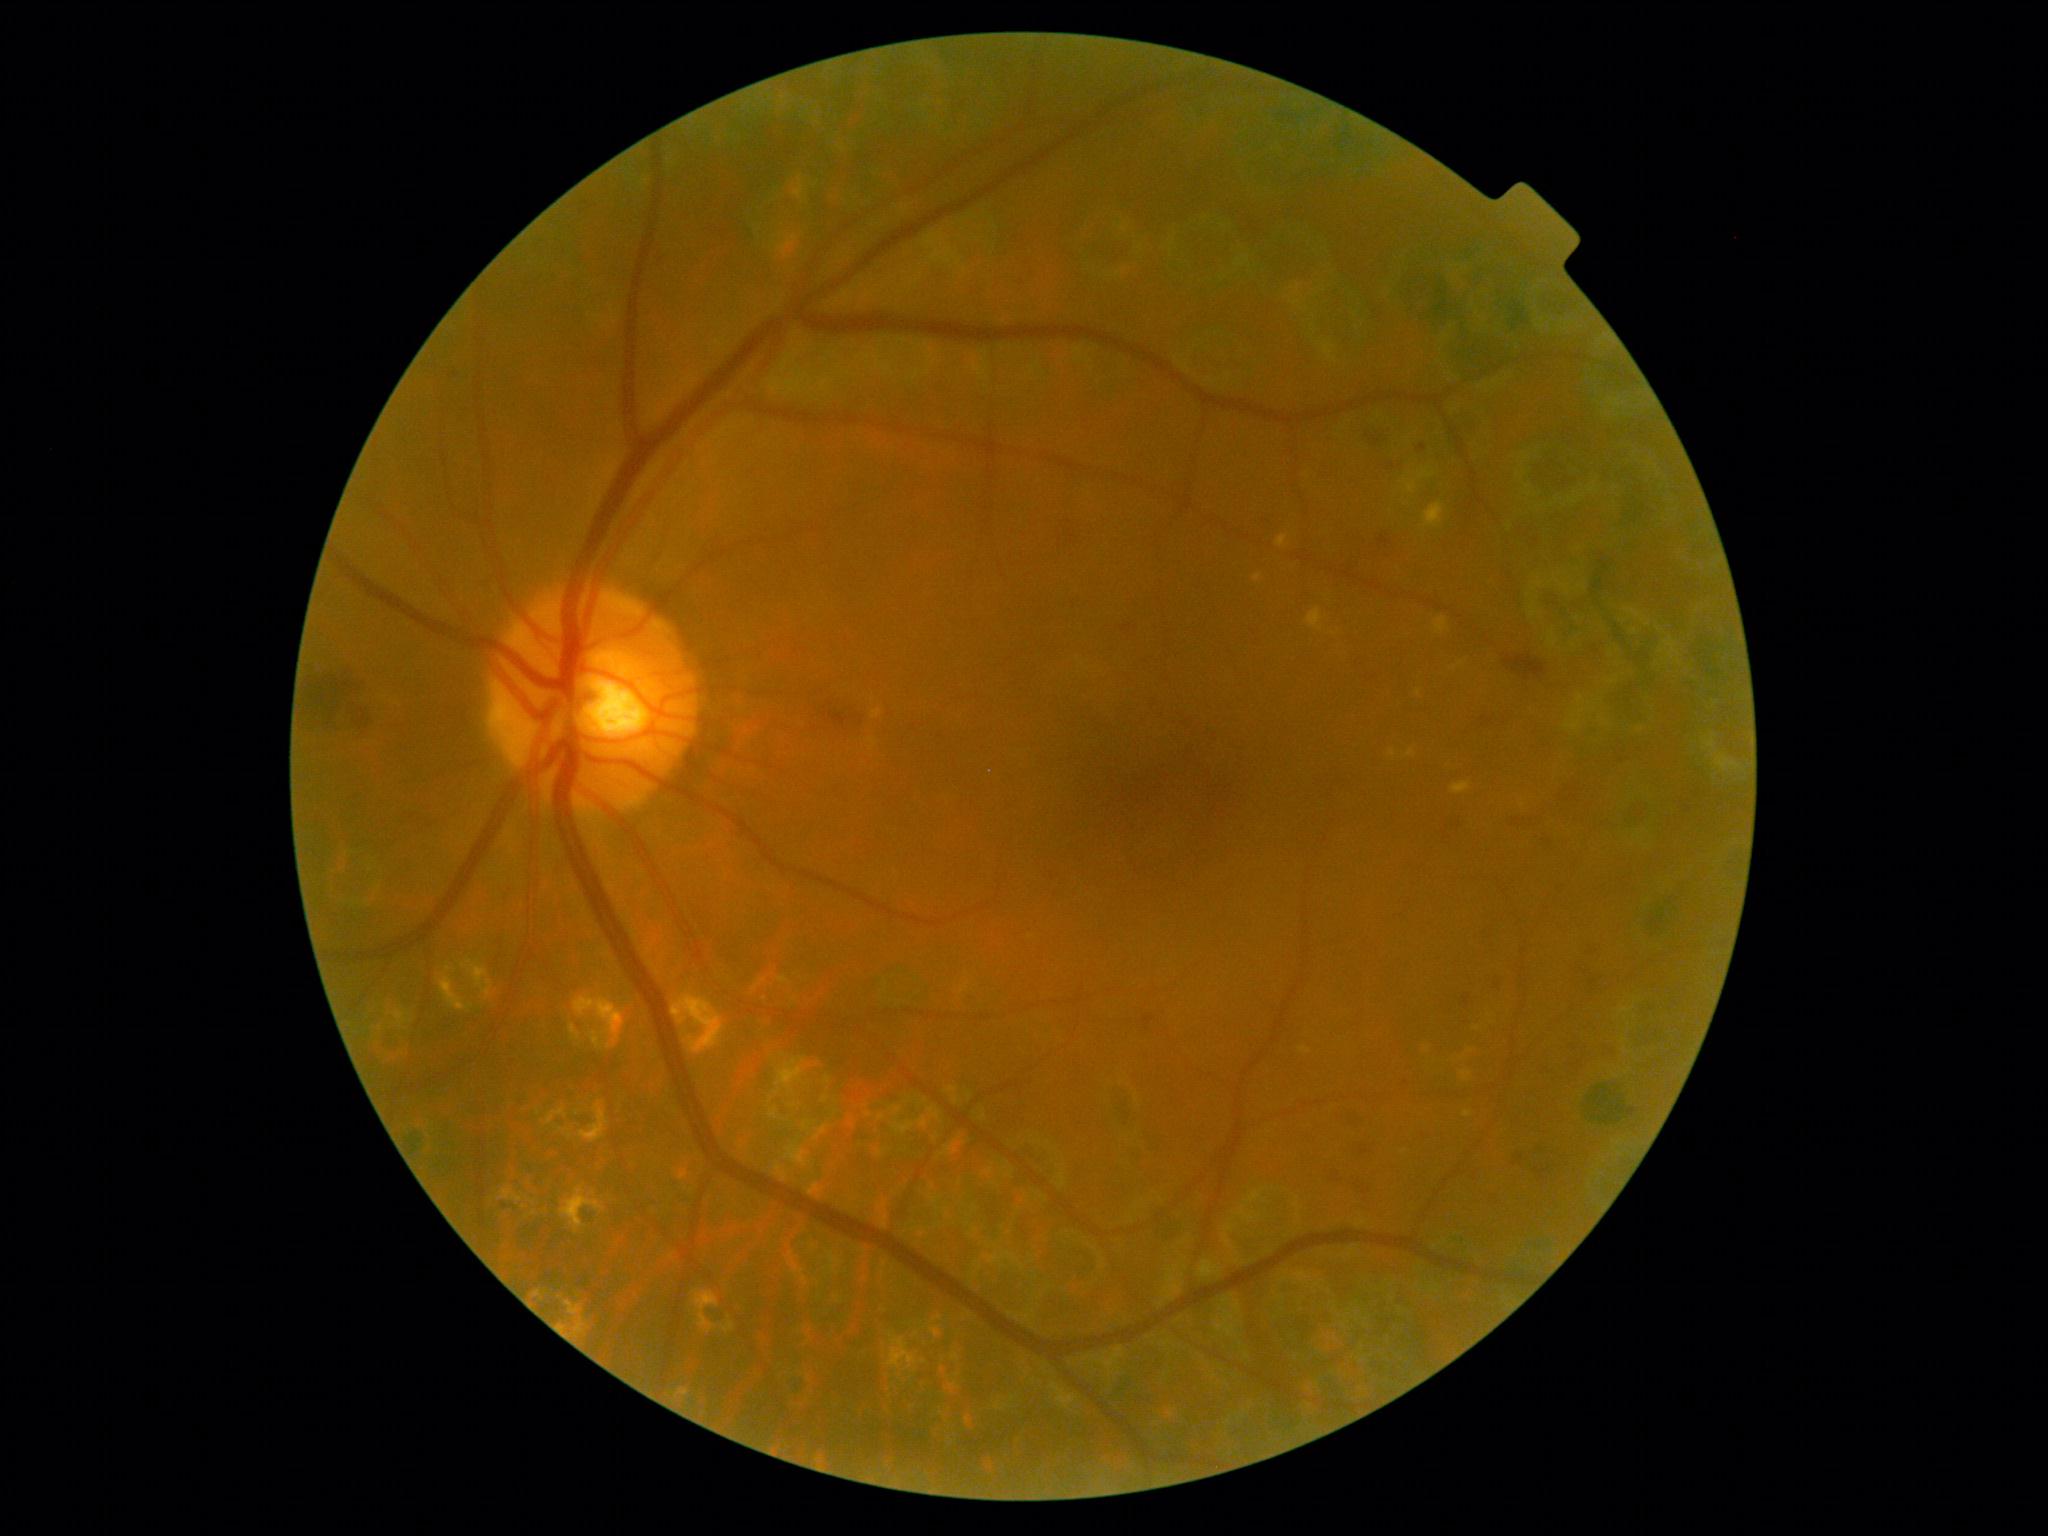

Diabetic retinopathy (DR): moderate non-proliferative diabetic retinopathy (grade 2) — more than just microaneurysms but less than severe NPDR
A subset of detected lesions:
- hemorrhages (HEs) (continued): Rect(1140, 1014, 1153, 1019), Rect(1505, 654, 1546, 681), Rect(1579, 969, 1601, 979), Rect(830, 713, 850, 727), Rect(1585, 939, 1602, 952), Rect(1508, 811, 1539, 824), Rect(1122, 618, 1133, 632), Rect(1325, 1170, 1337, 1181), Rect(1378, 536, 1393, 548), Rect(1348, 1110, 1358, 1120), Rect(1463, 991, 1475, 1008)